Fundus photo — 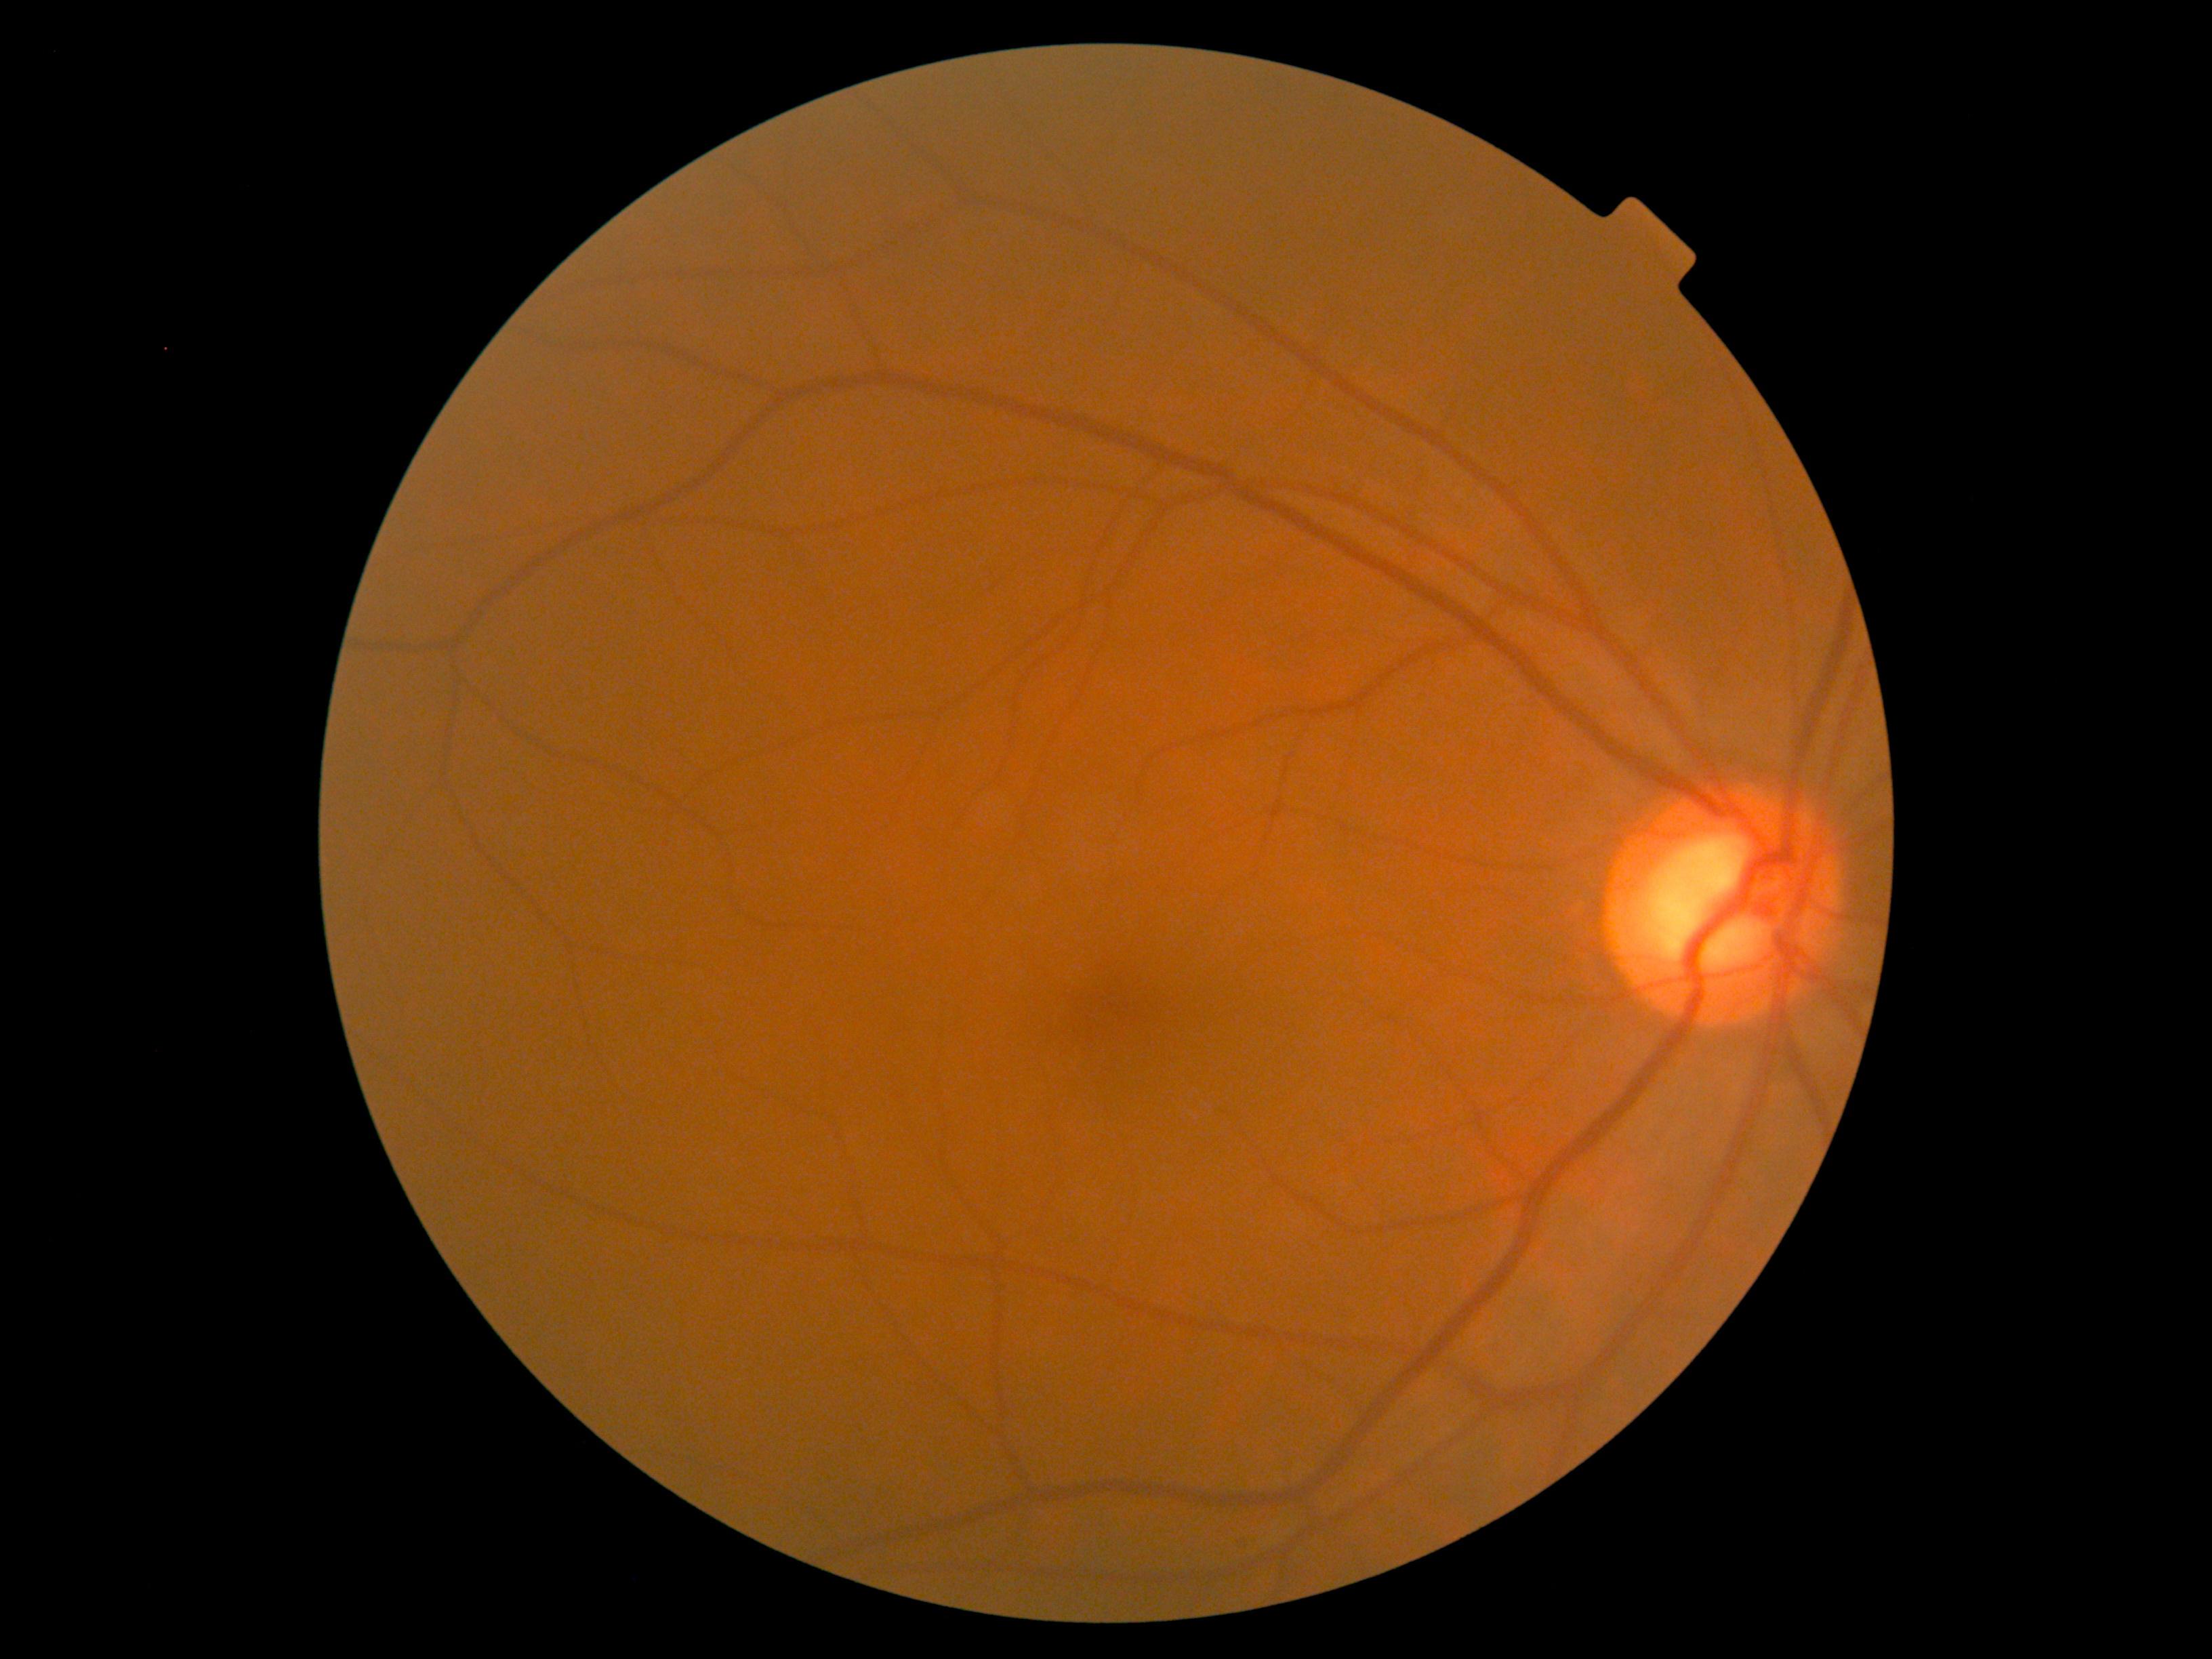
Annotations:
- DR impression: negative for DR
- diabetic retinopathy grade: 0/4 — no visible signs of diabetic retinopathy